Wide-field fundus photograph of an infant. Captured with the Clarity RetCam 3 (130° field of view). Image size 640x480 — 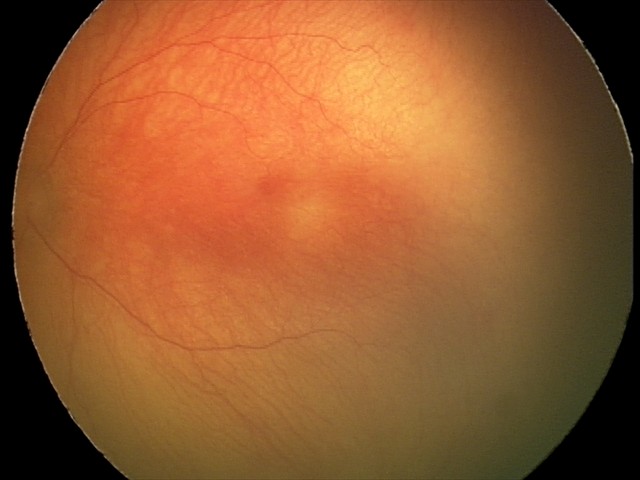

Series diagnosed as A-ROP (aggressive ROP).